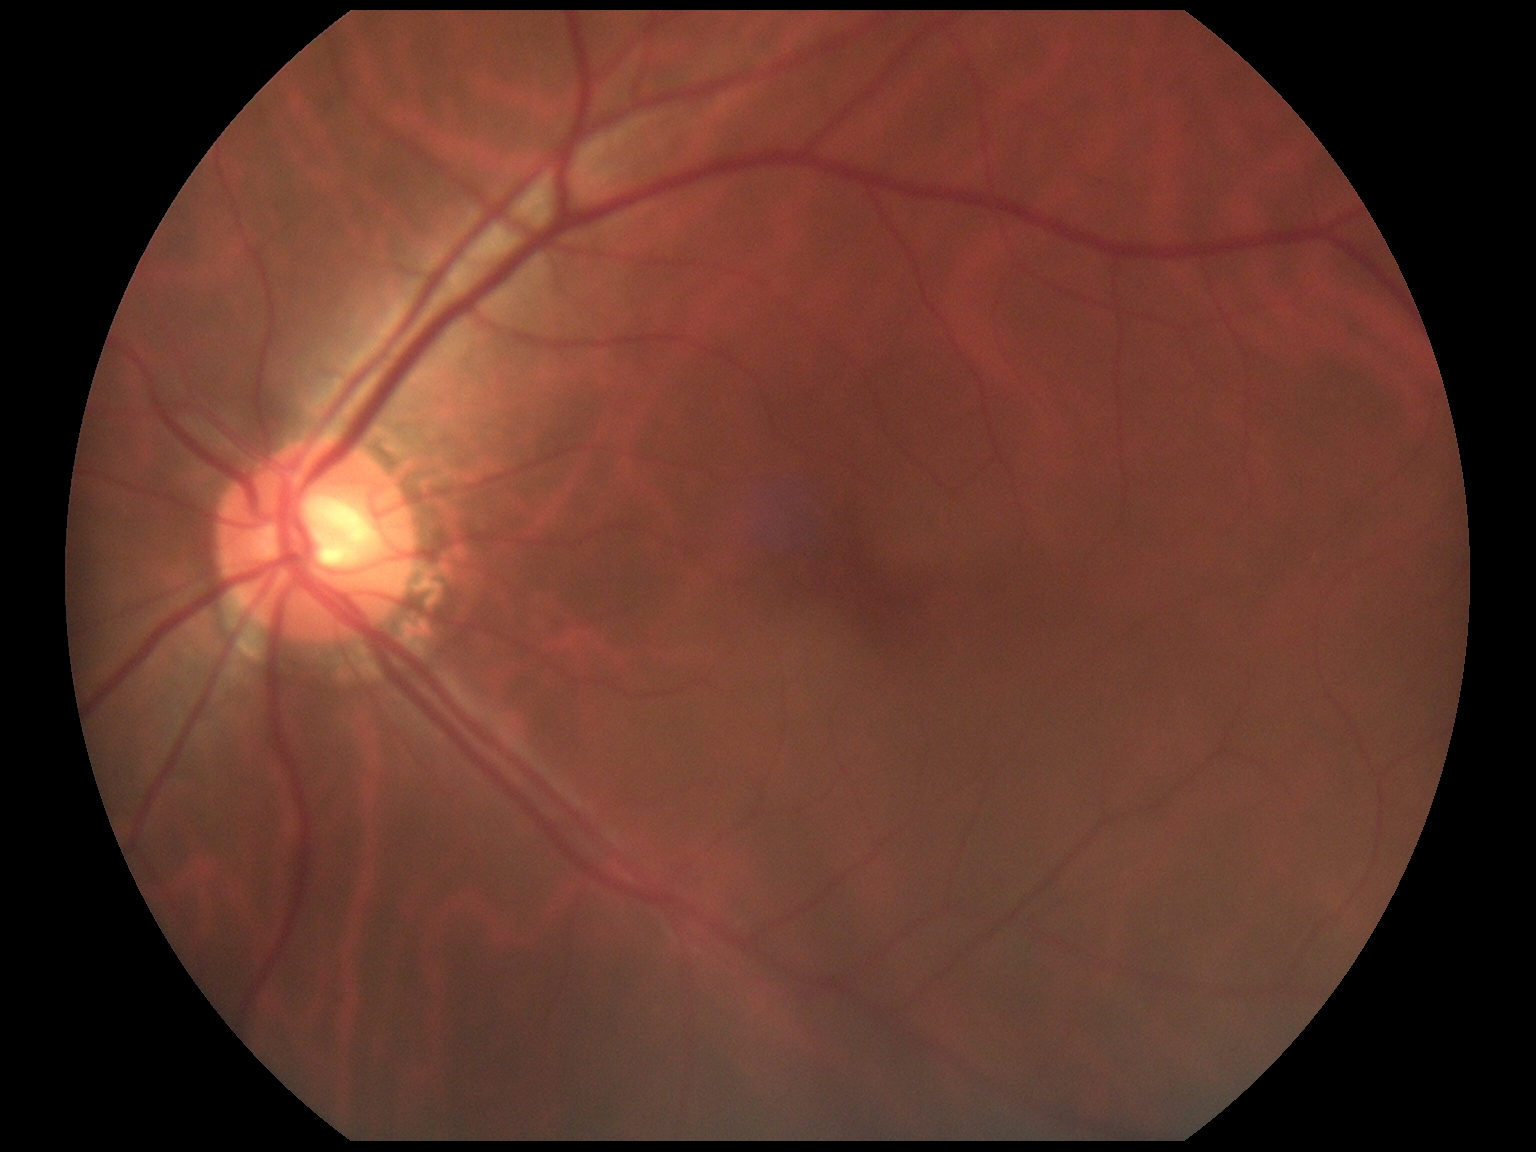 Findings:
- retinopathy: grade 0